848x848px.
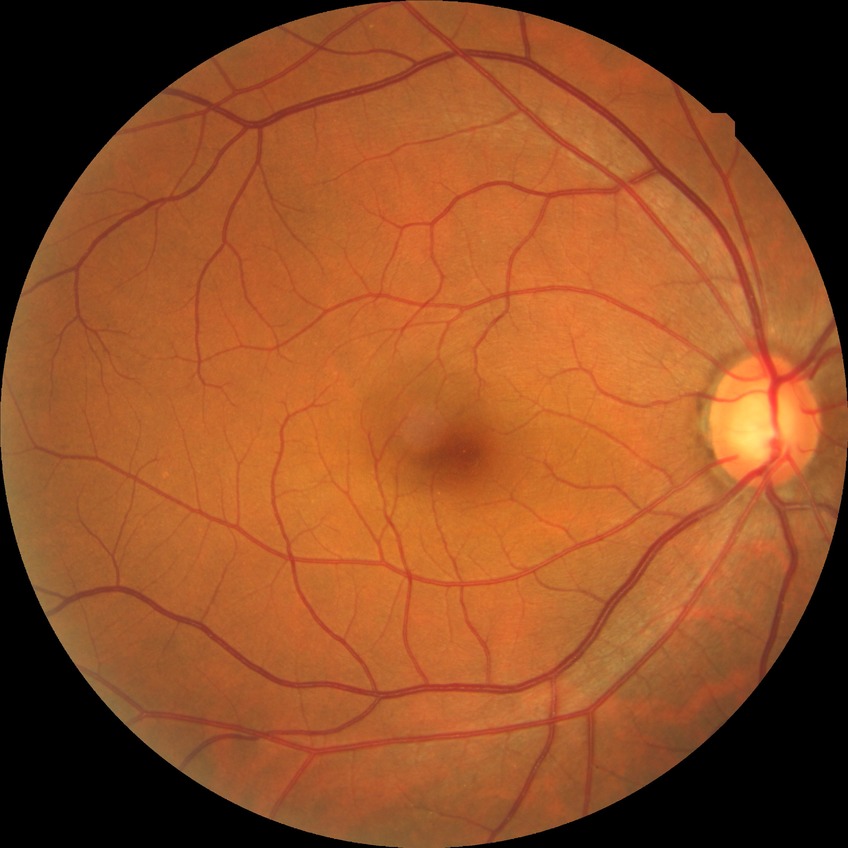
Davis grade: NDR.